240x240px; captured without pupil dilation; optic disc region crop:
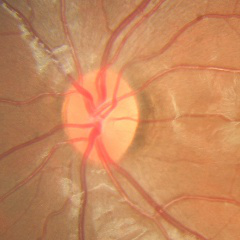

Findings consistent with no signs of glaucoma.